Image size 1924x1556; CFP
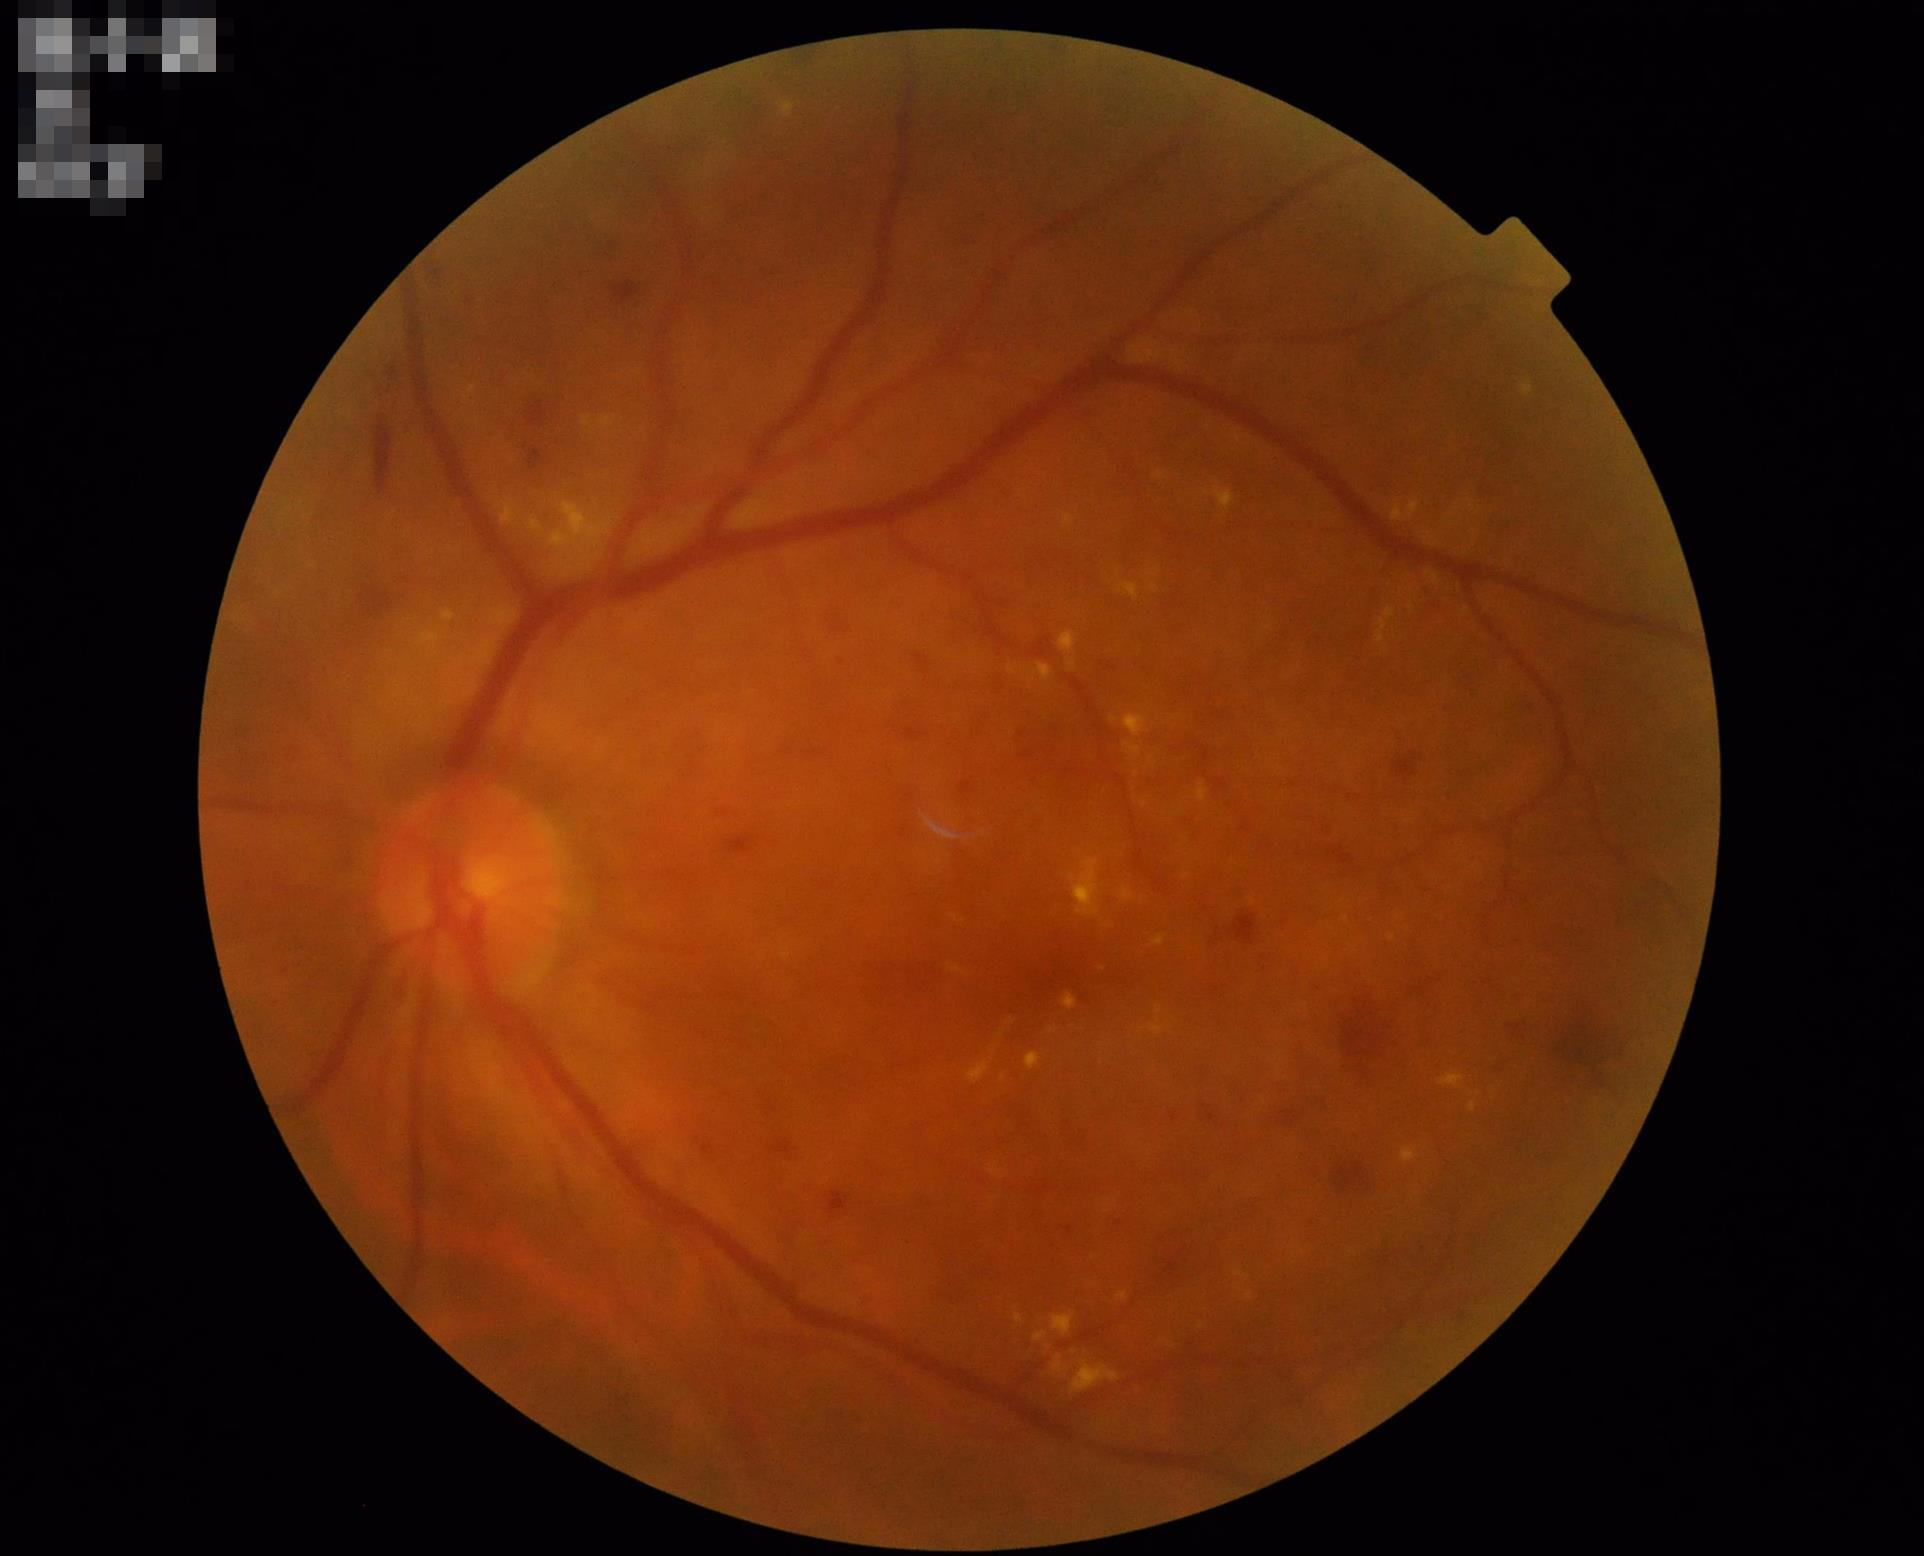
Focus = in focus
Illumination = adequate
Overall = adequate
Contrast = satisfactory